512 by 512 pixels — 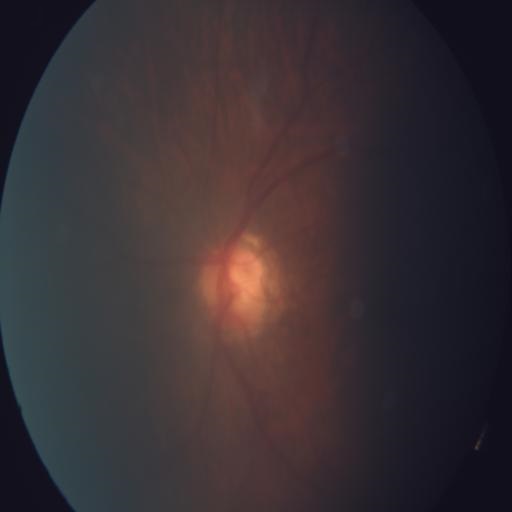

Color fundus photograph showing media haze.